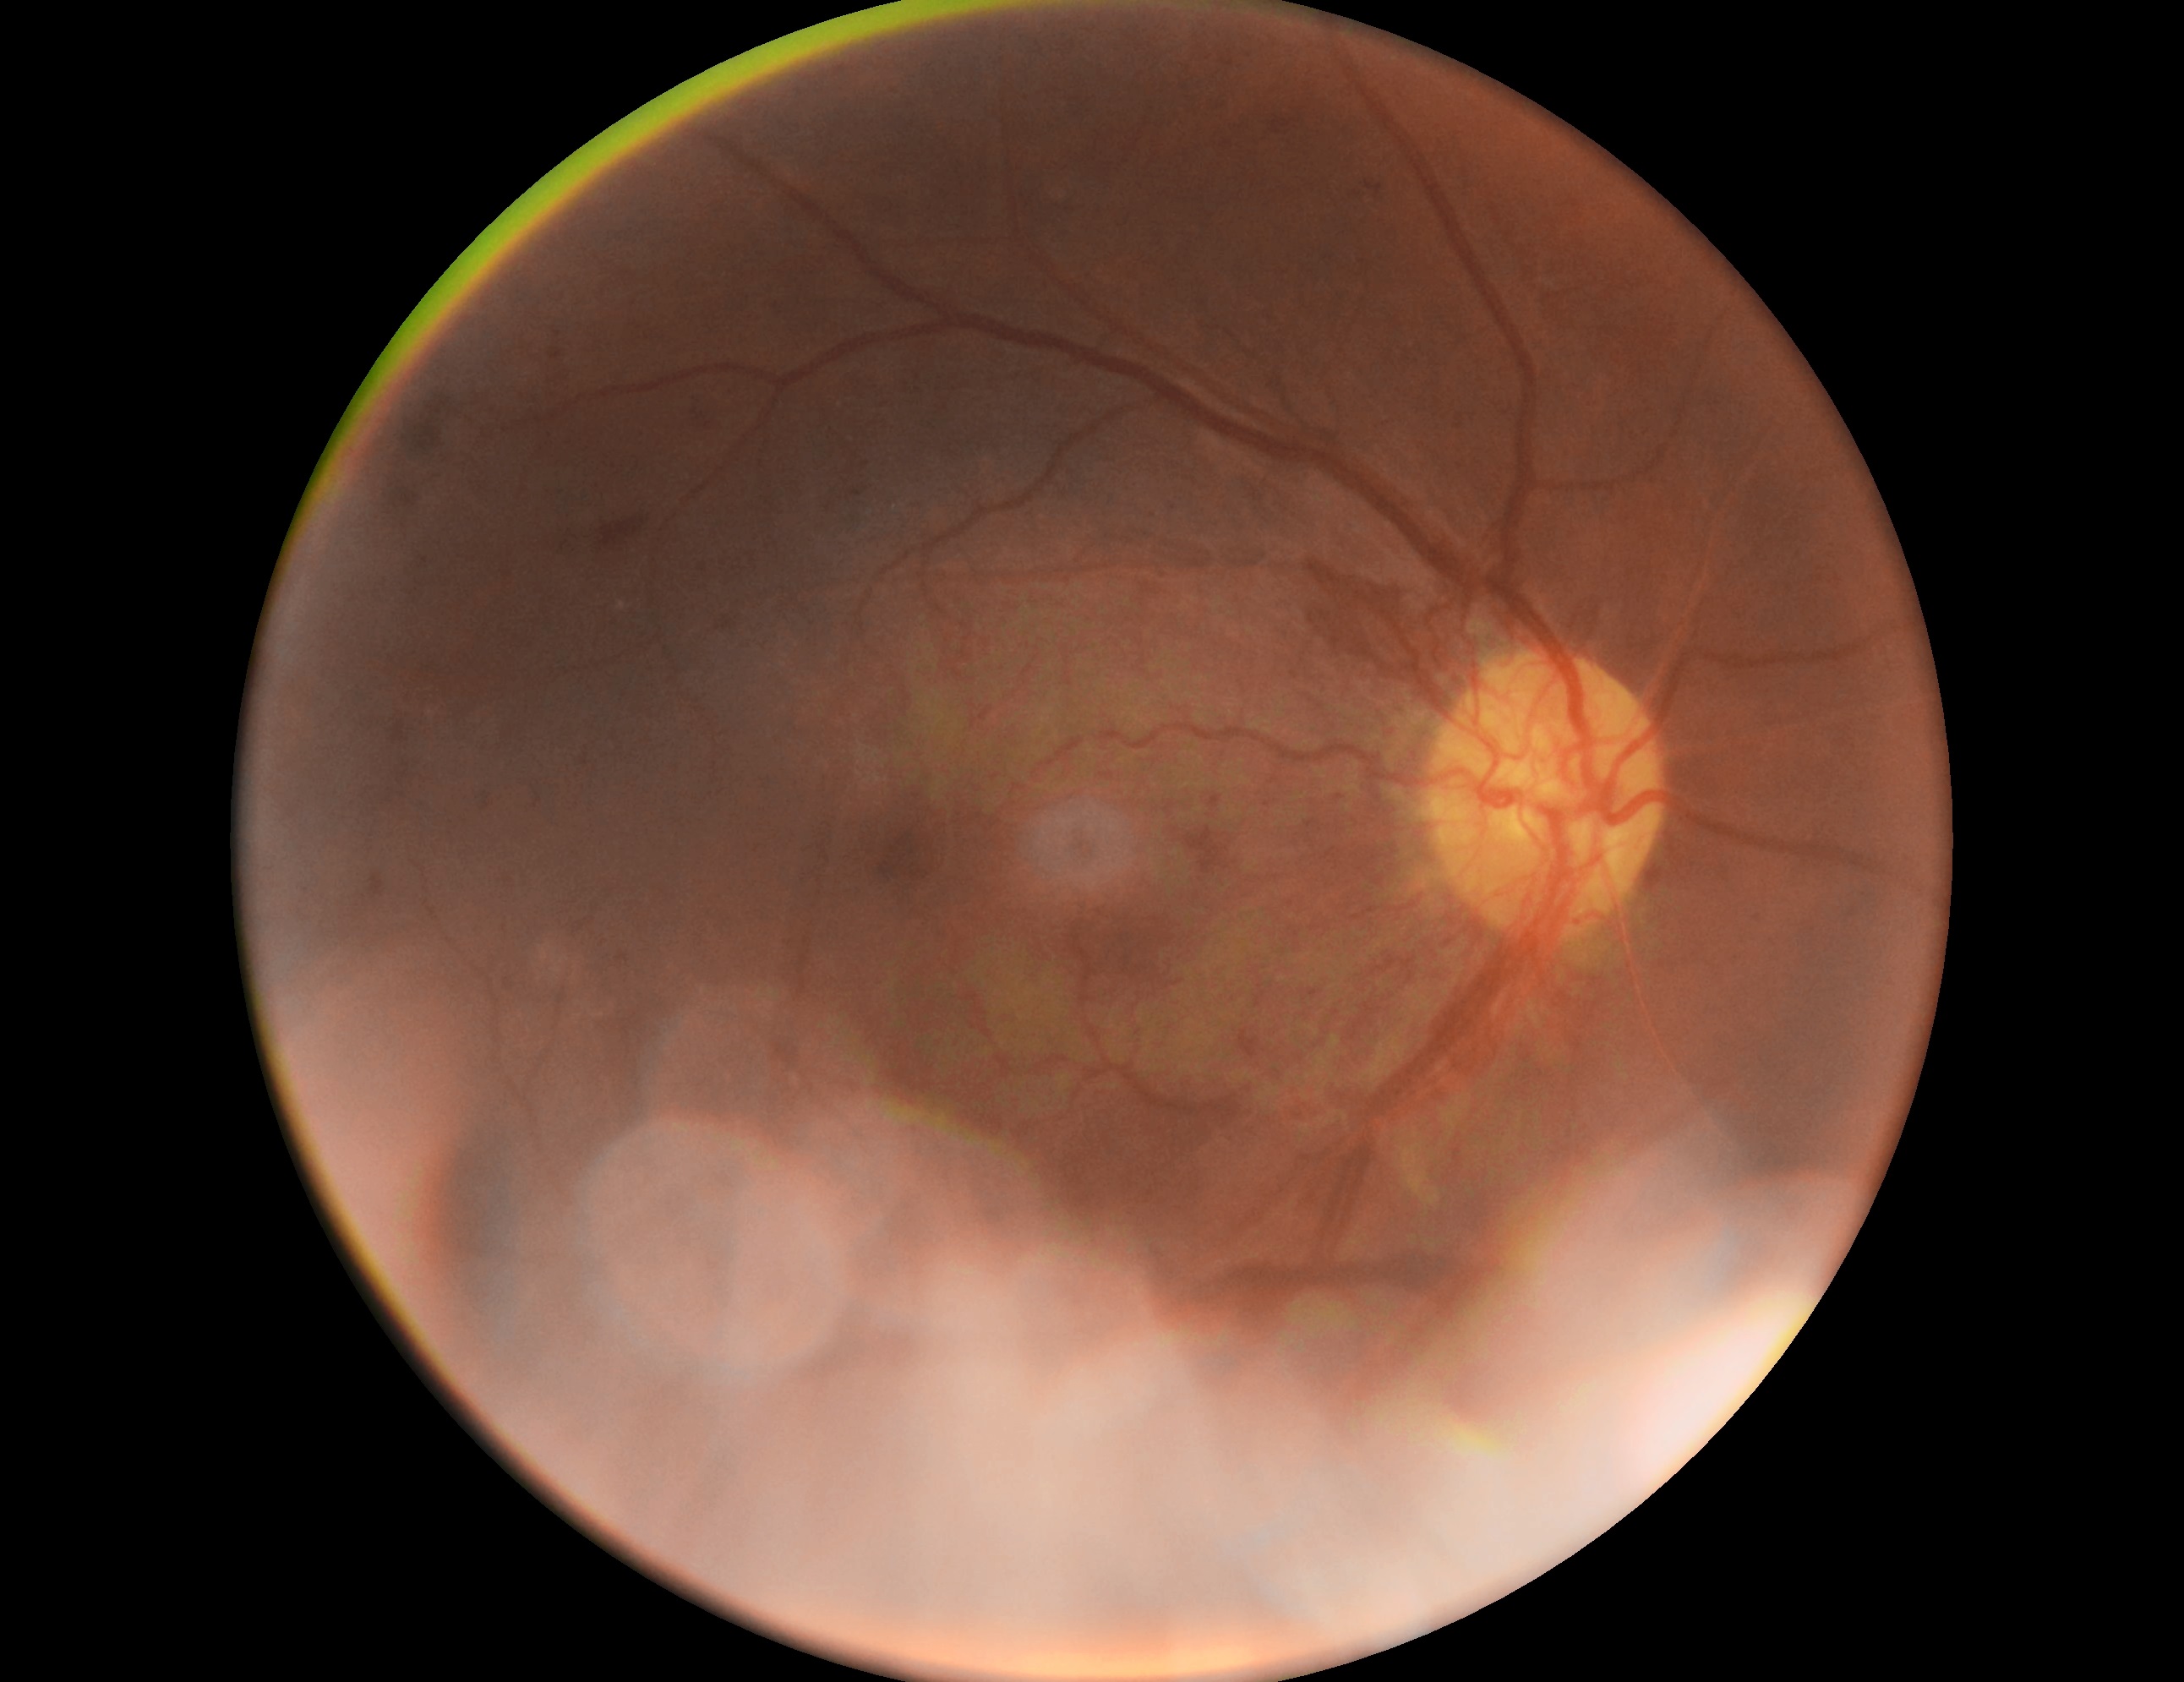 DR stage: proliferative diabetic retinopathy (grade 4) — neovascularization and/or vitreous/pre-retinal hemorrhage.